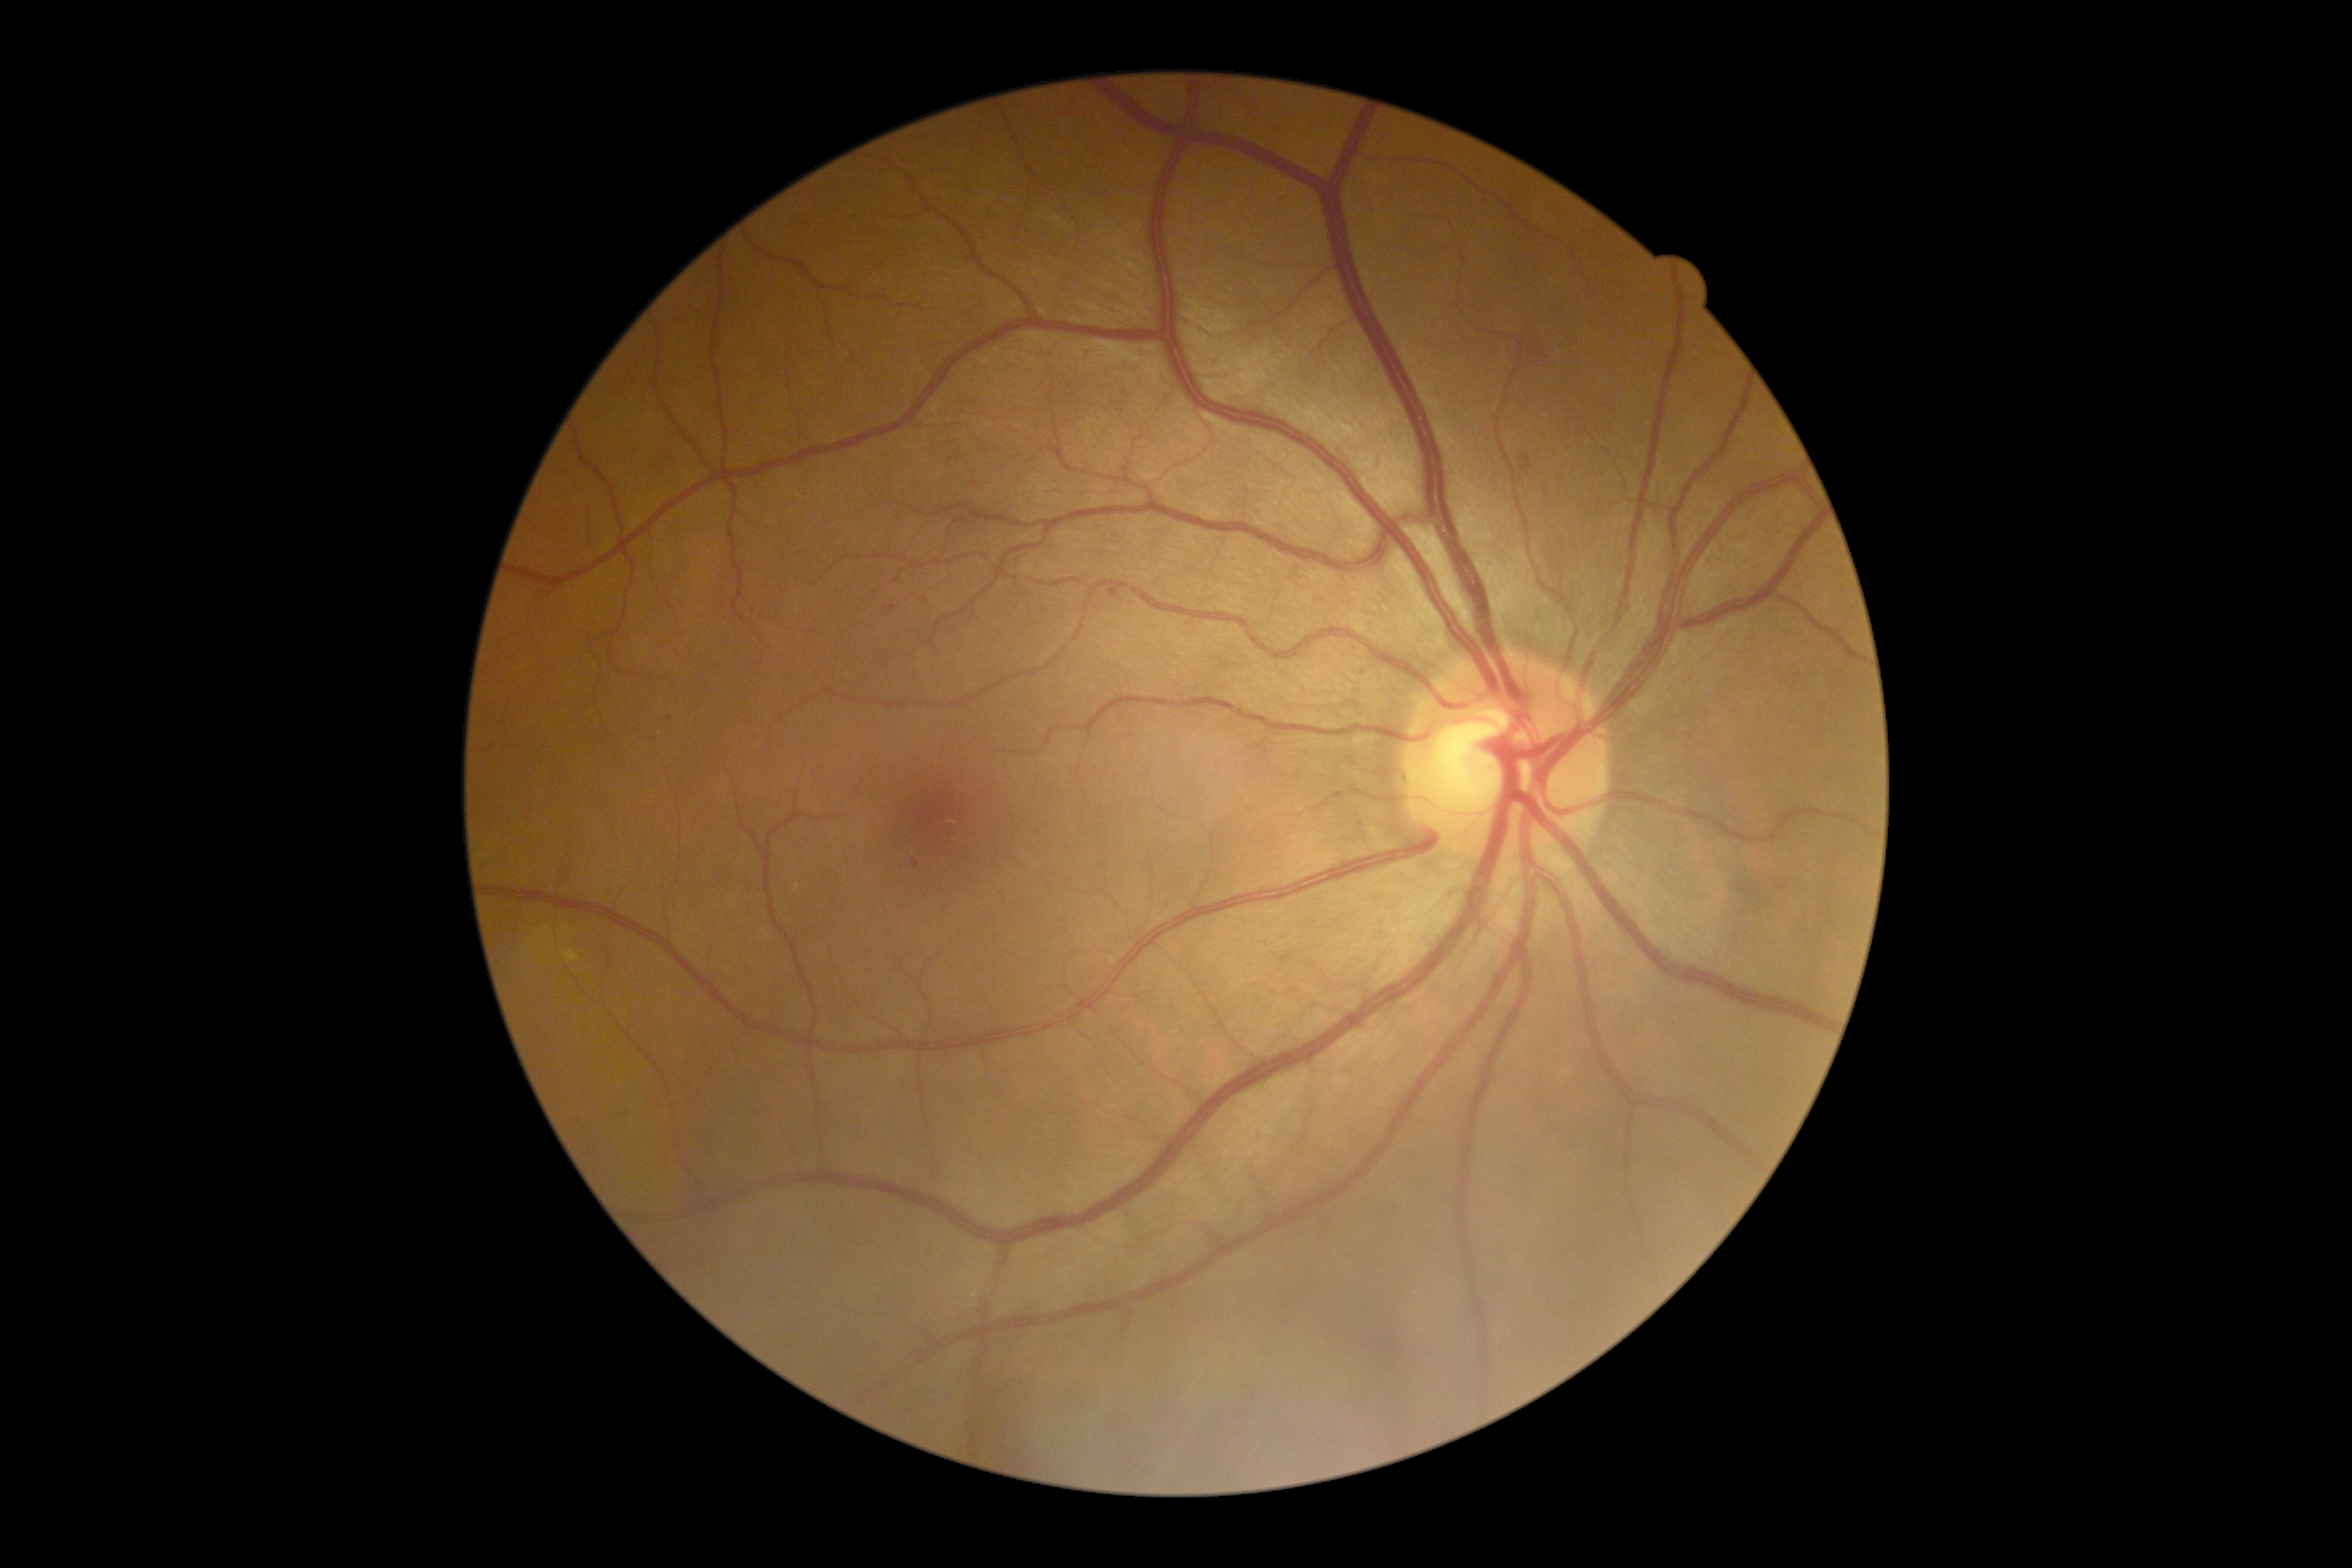

DR: 2.